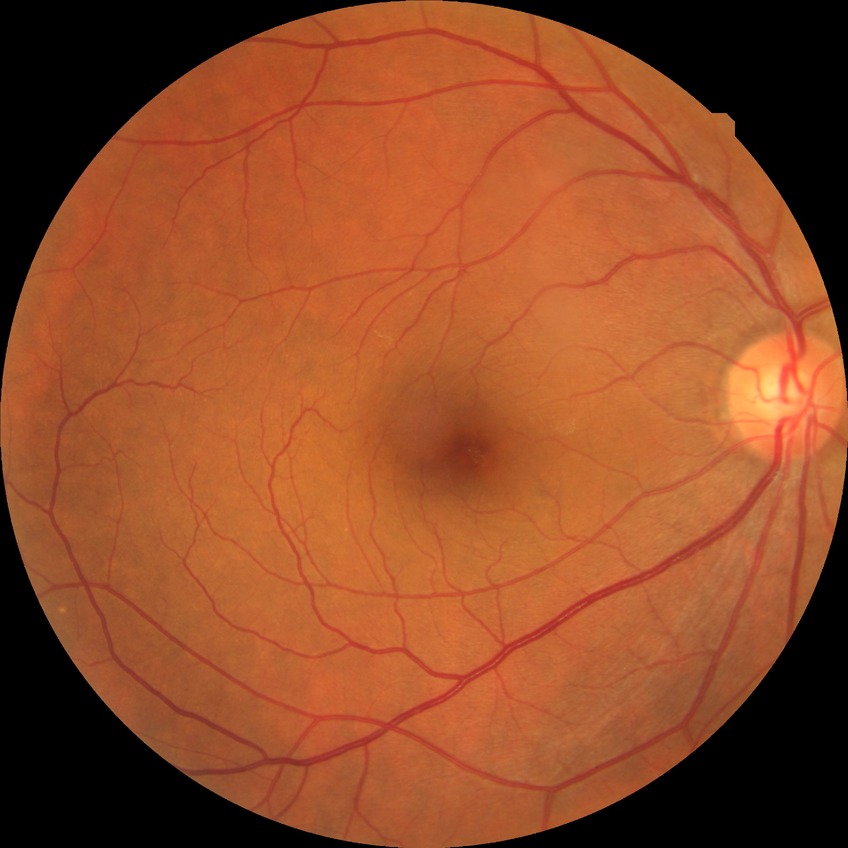
Findings:
– diabetic retinopathy (DR) — NDR (no diabetic retinopathy)